848 by 848 pixels. Posterior pole color fundus photograph:
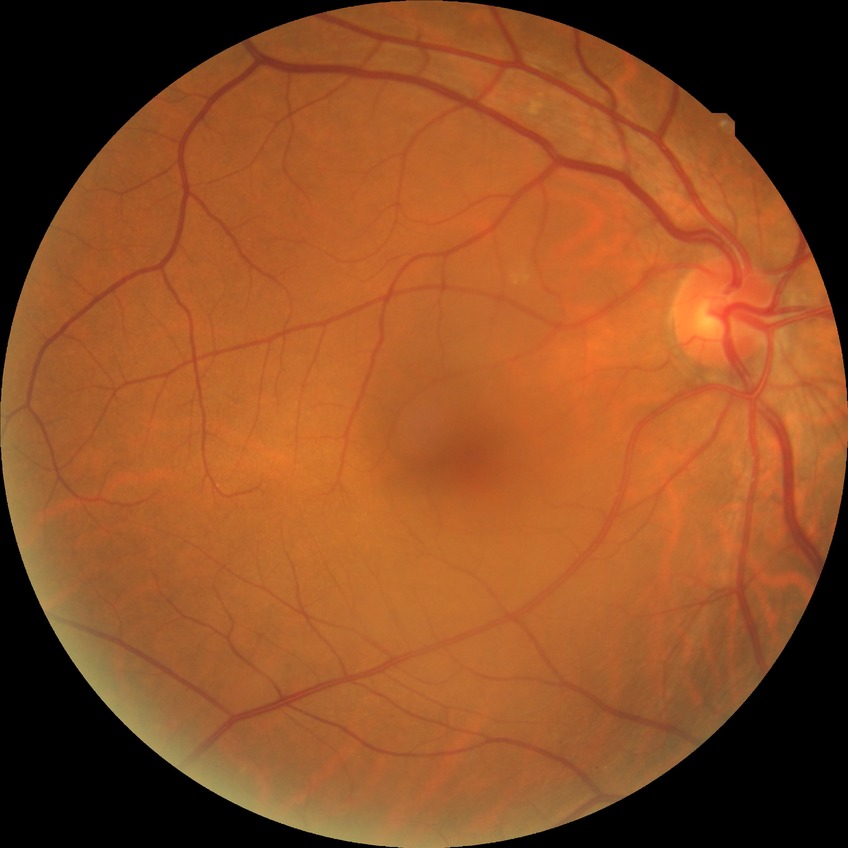

Assessment:
- diabetic retinopathy stage — no diabetic retinopathy